640x480 · wide-field fundus image from infant ROP screening — 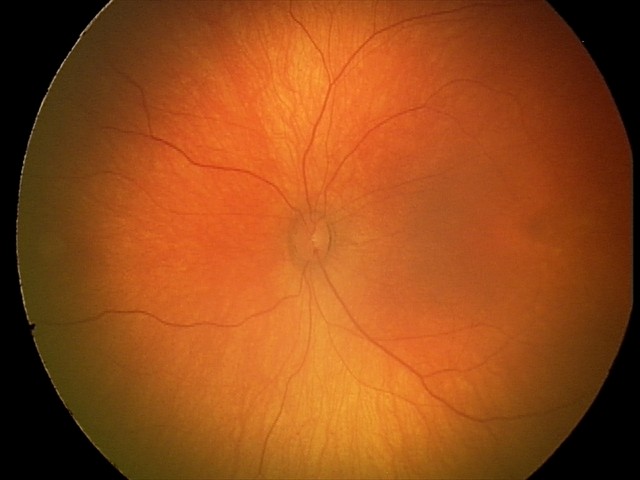
Q: What is the diagnosis from this examination?
A: physiological finding